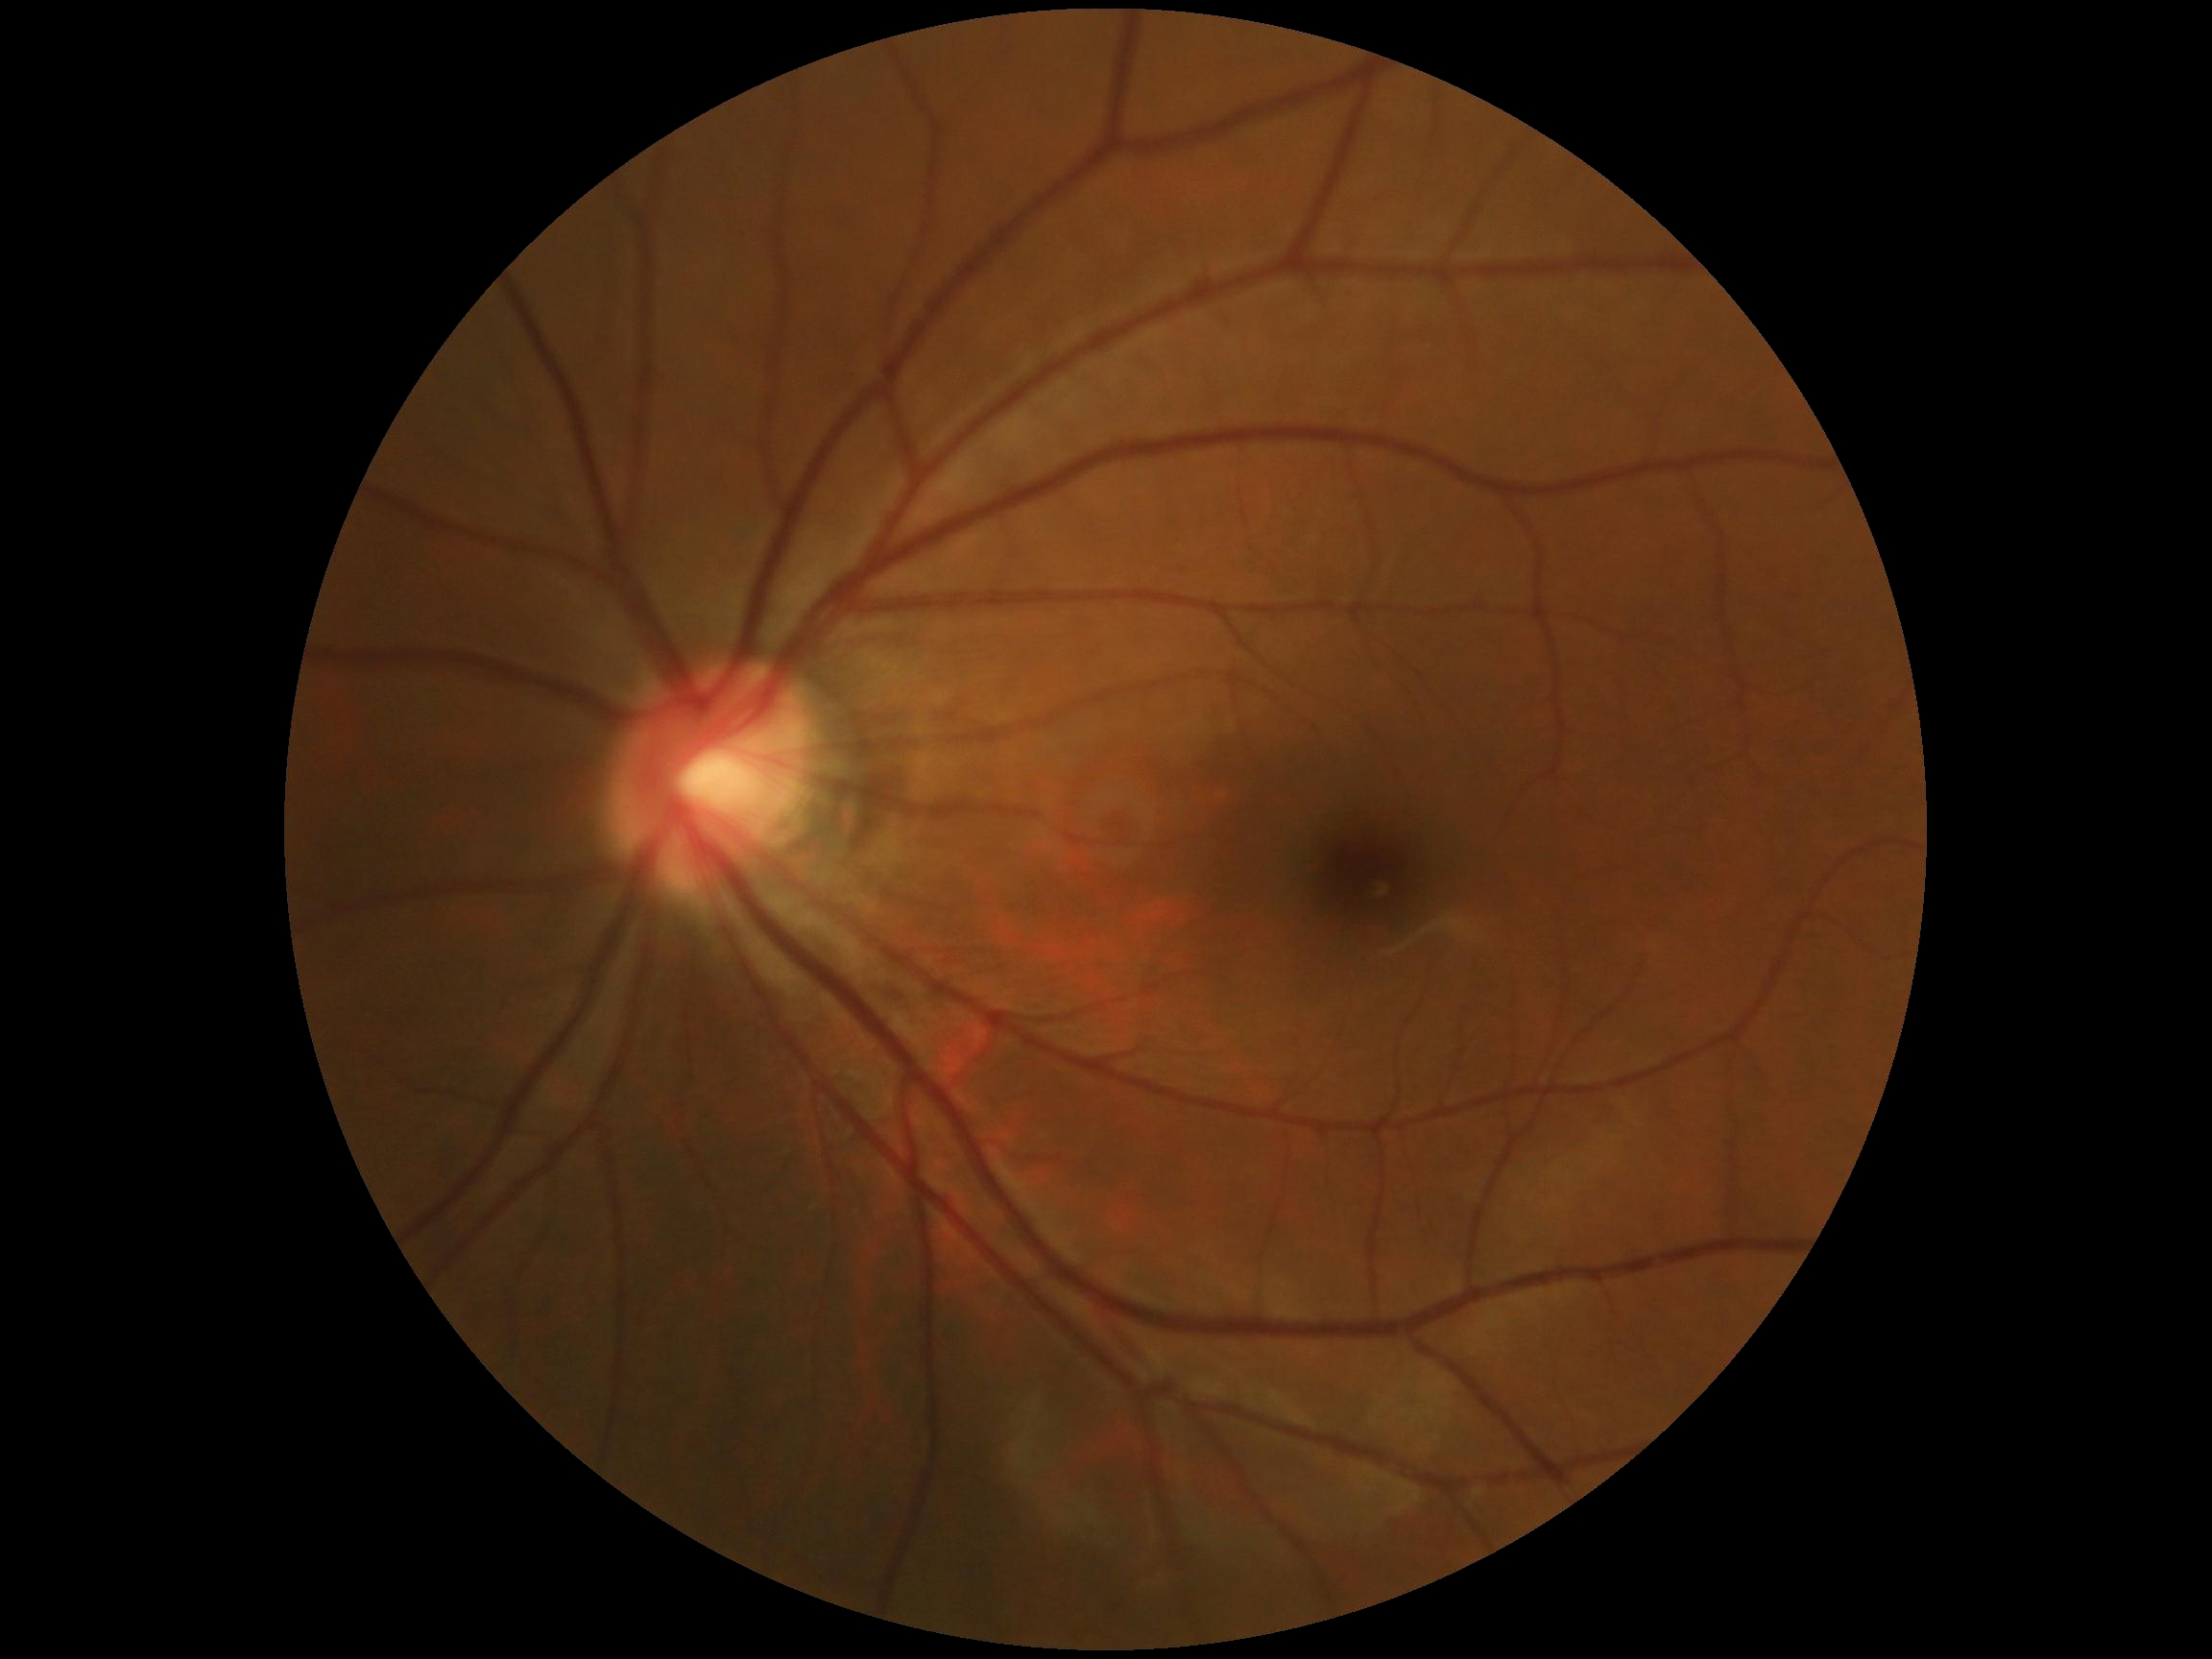 diabetic retinopathy (DR): grade 0 (no apparent retinopathy).